45-degree field of view.
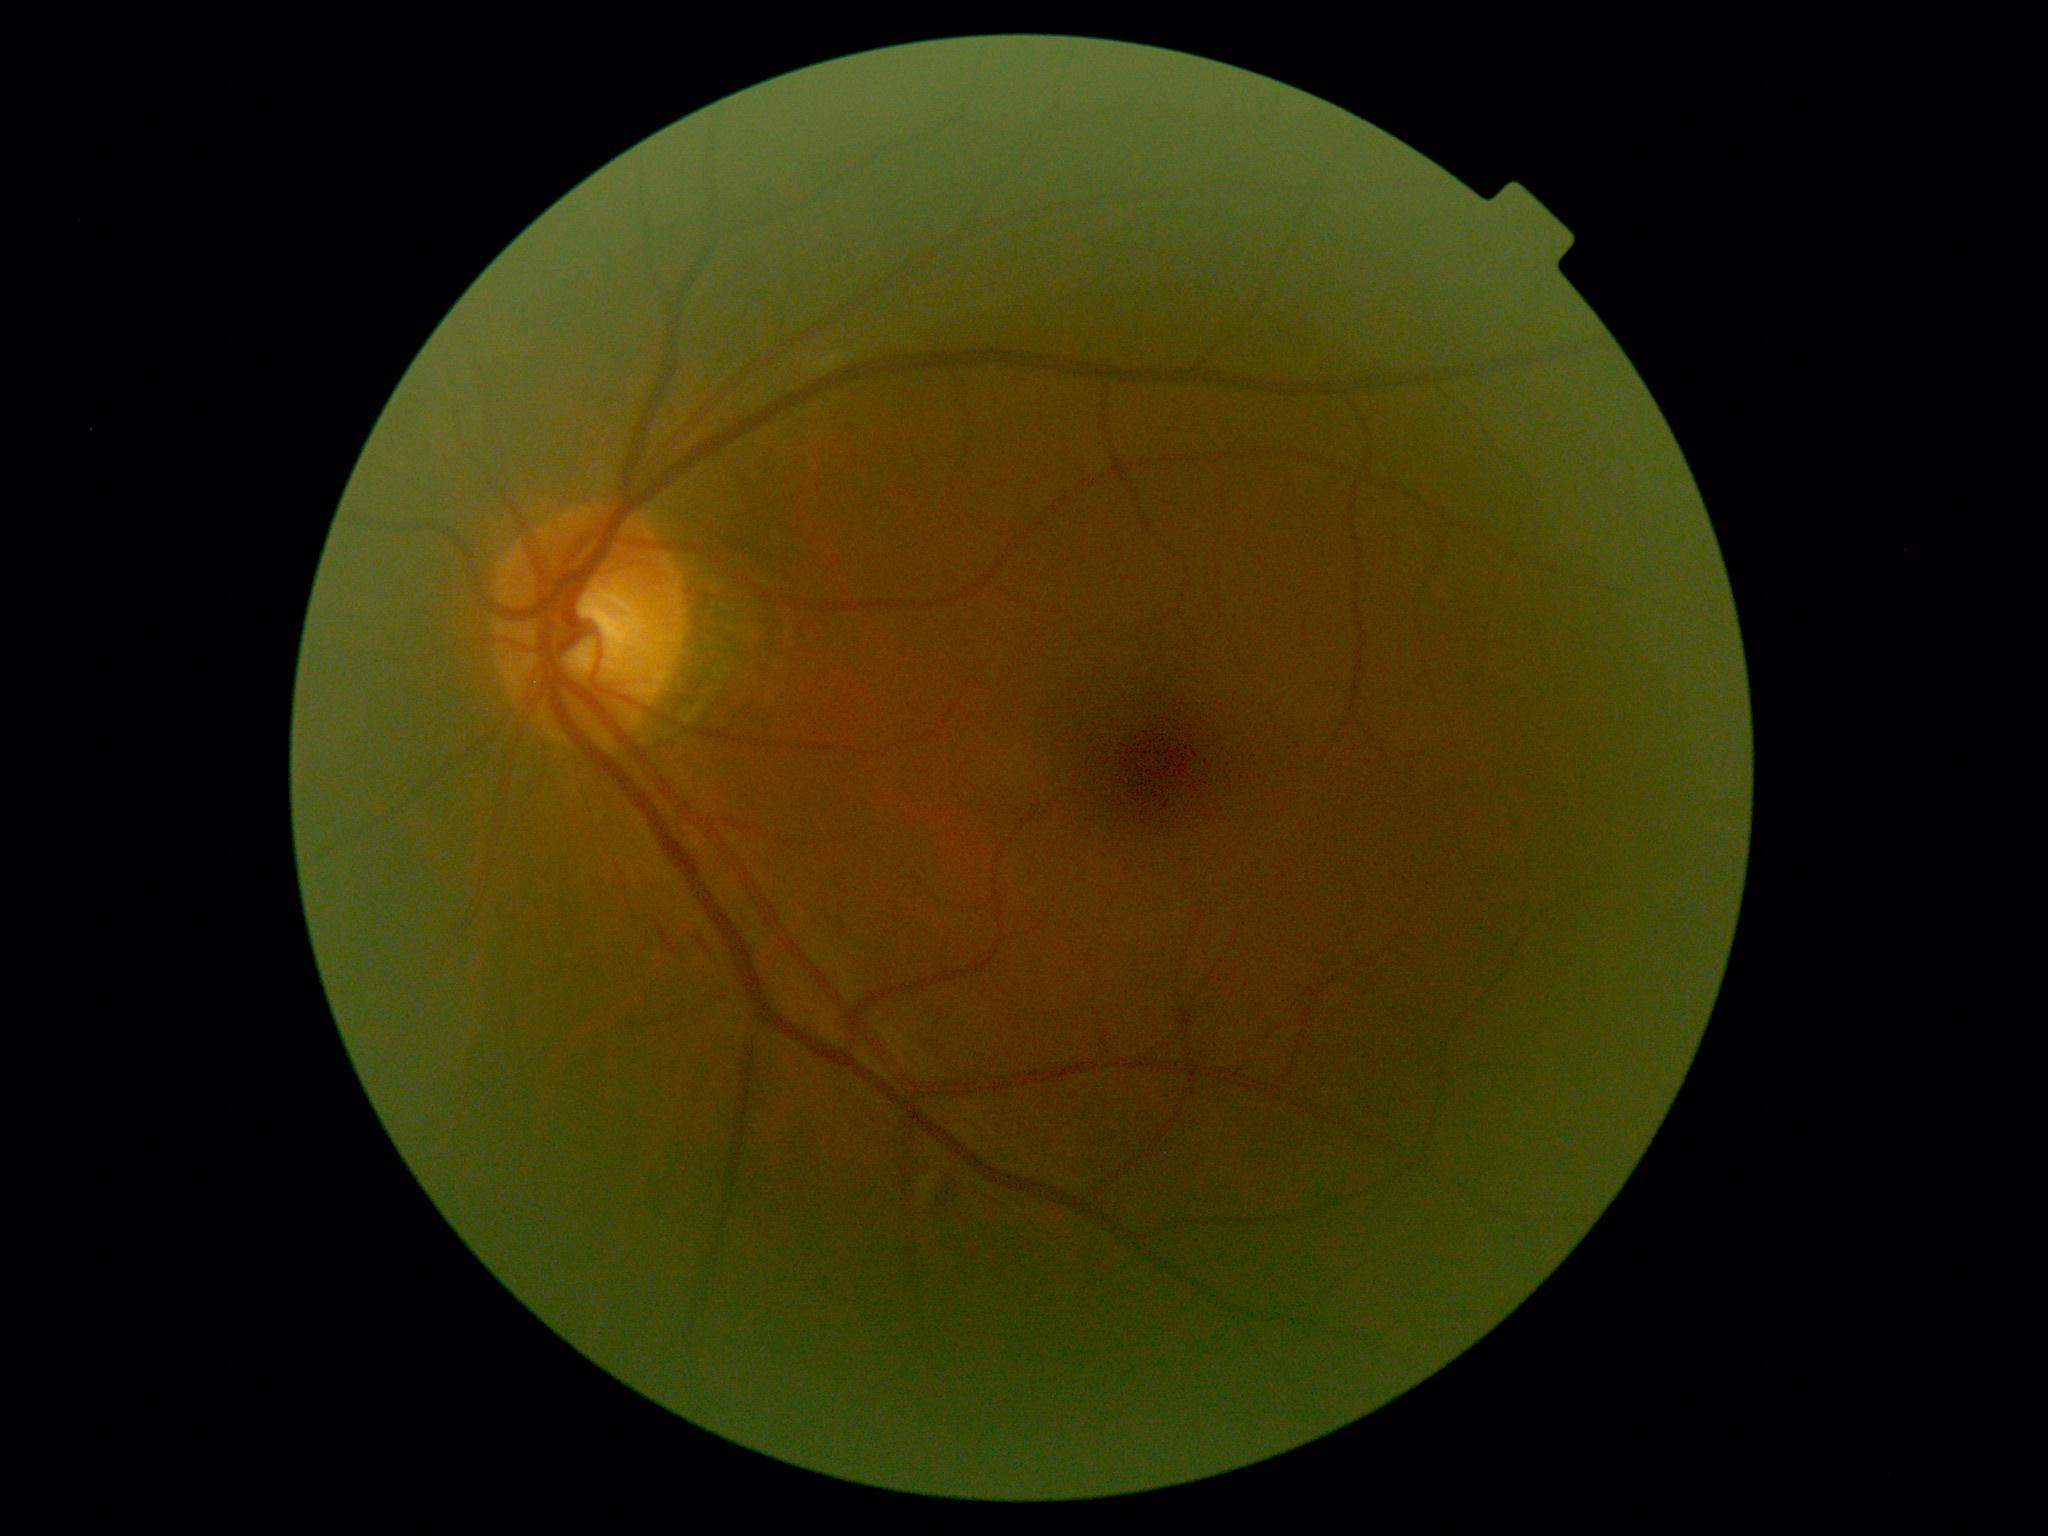 DR stage is grade 2 (moderate NPDR).